2361x1568. Dilated-pupil acquisition. Color fundus image: 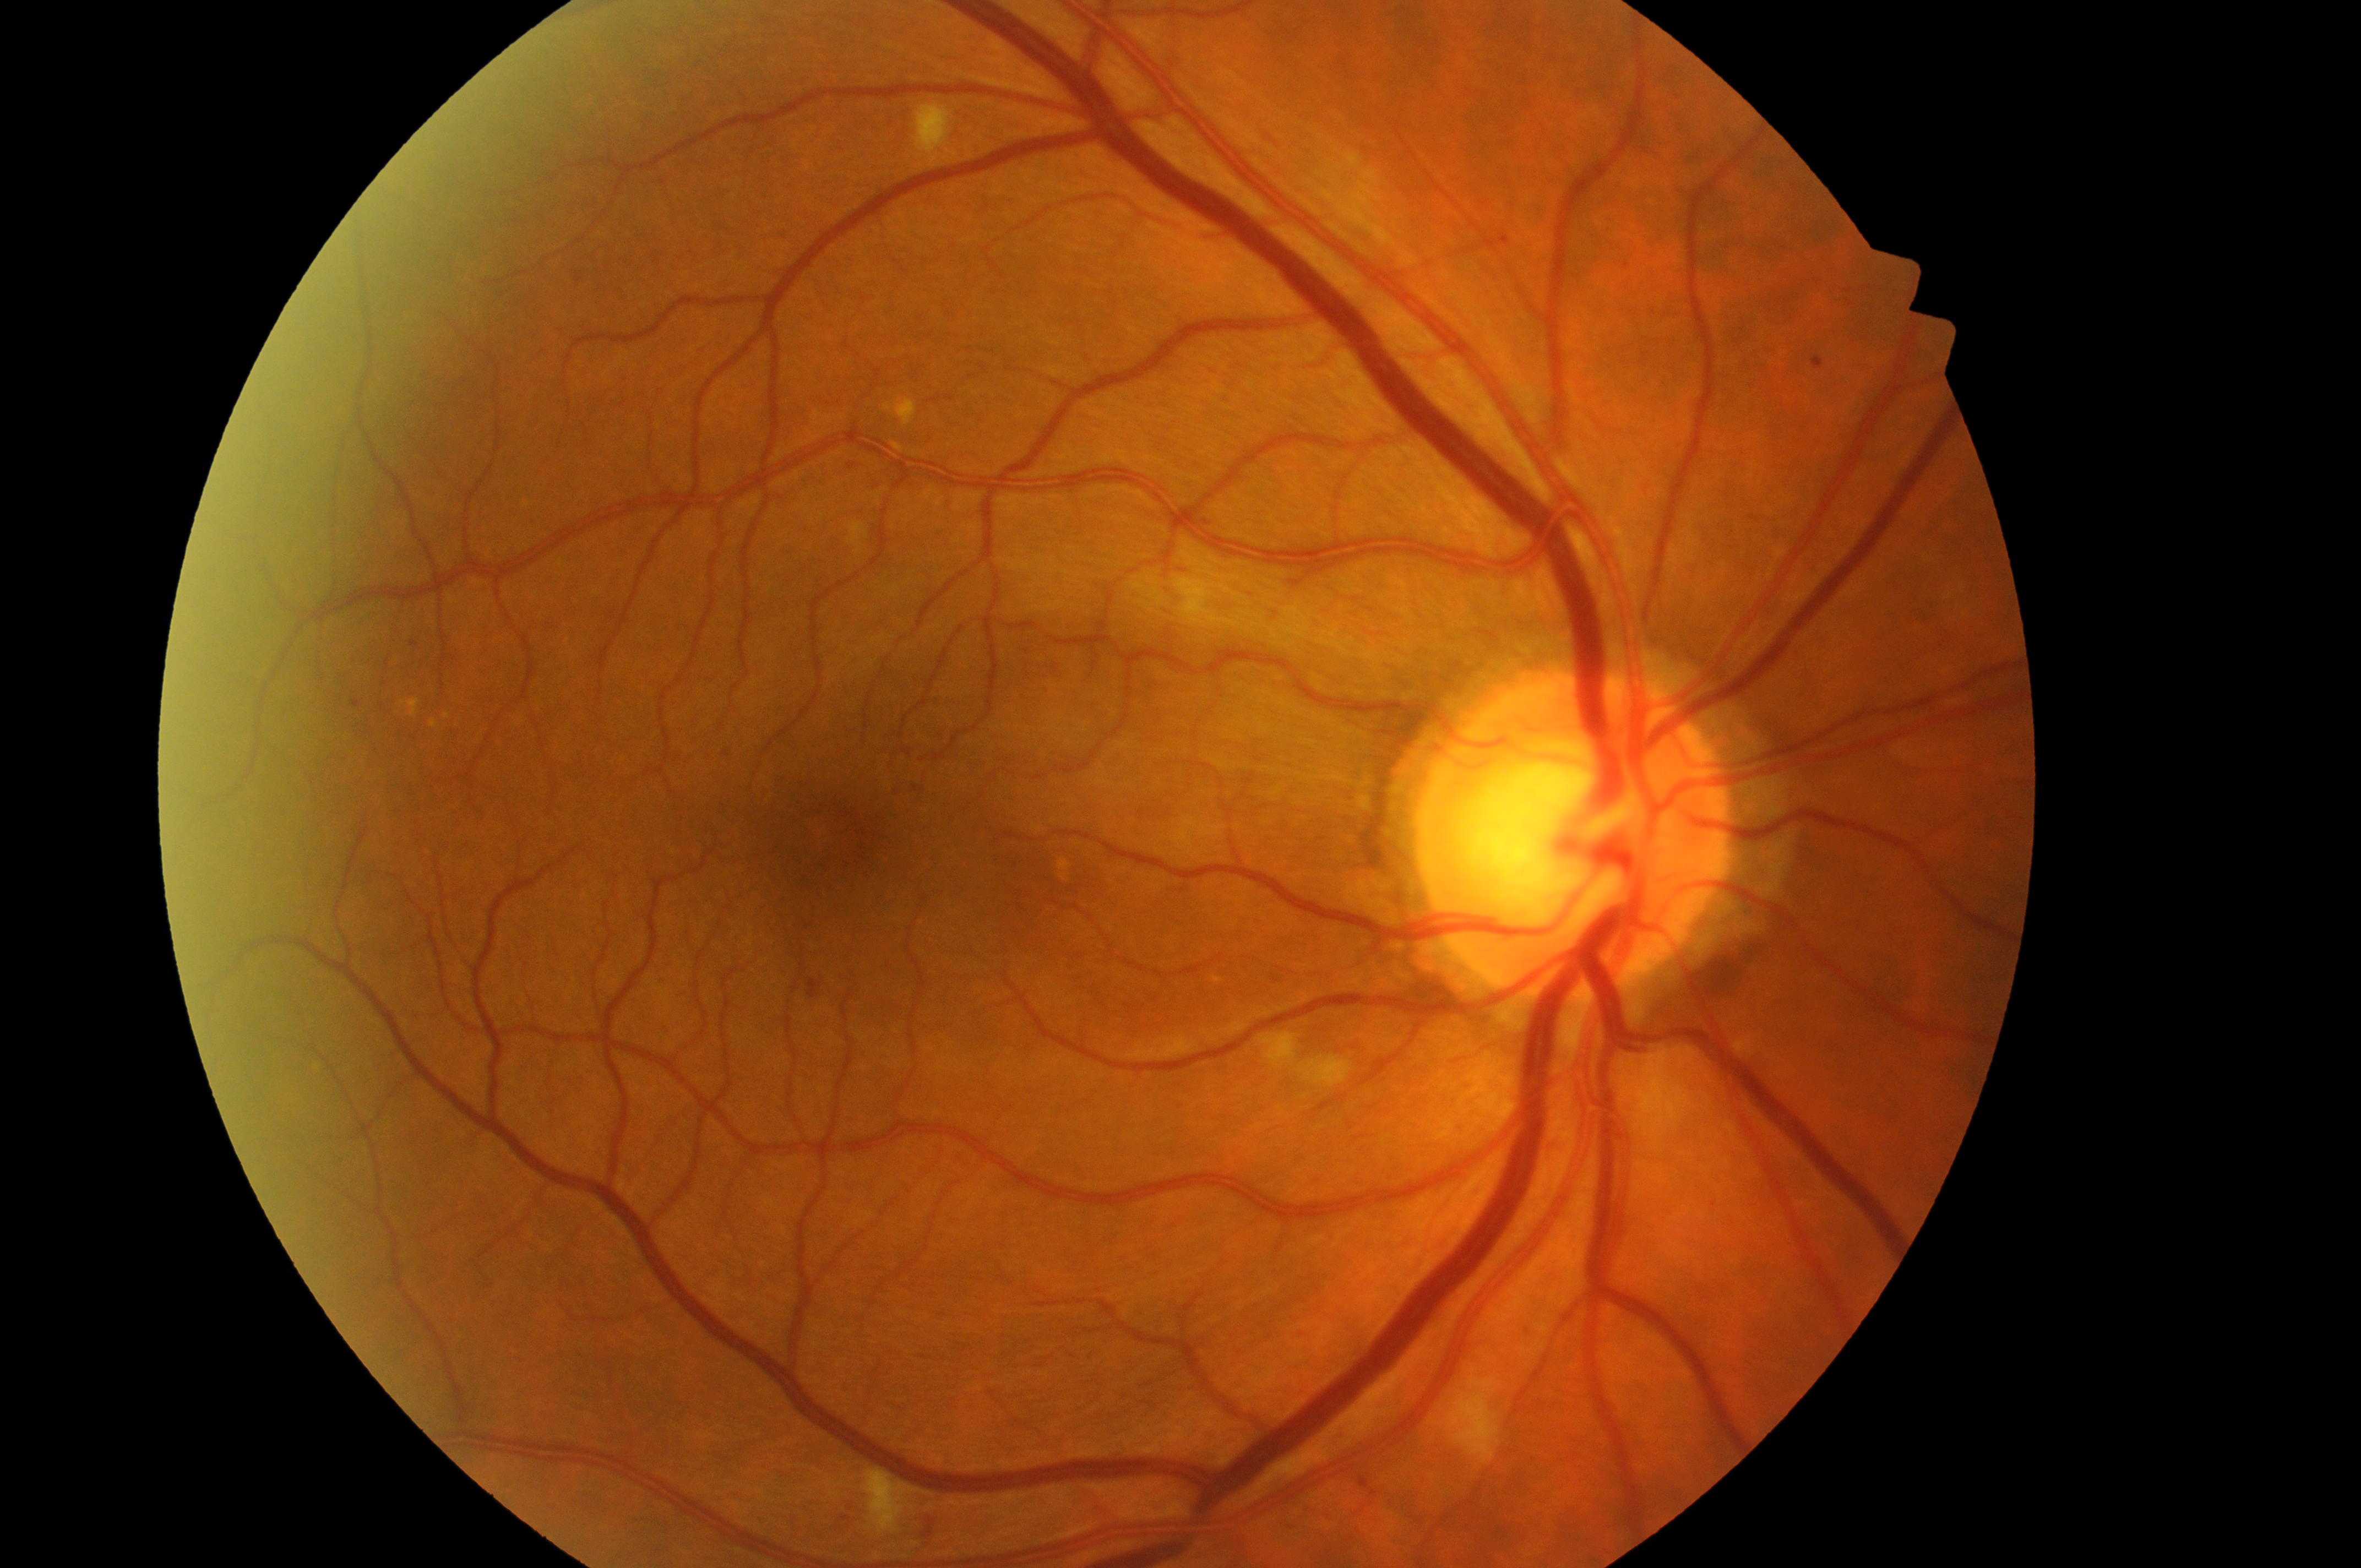

The fovea center is at [829, 835]. DR grade is 2 (moderate NPDR). The retinopathy is classified as non-proliferative diabetic retinopathy. Eye: right. DME risk: low risk (grade 1). The optic disc is at [1564, 843].